Phoenix ICON wide-field infant fundus image. 1240 x 1240 pixels.
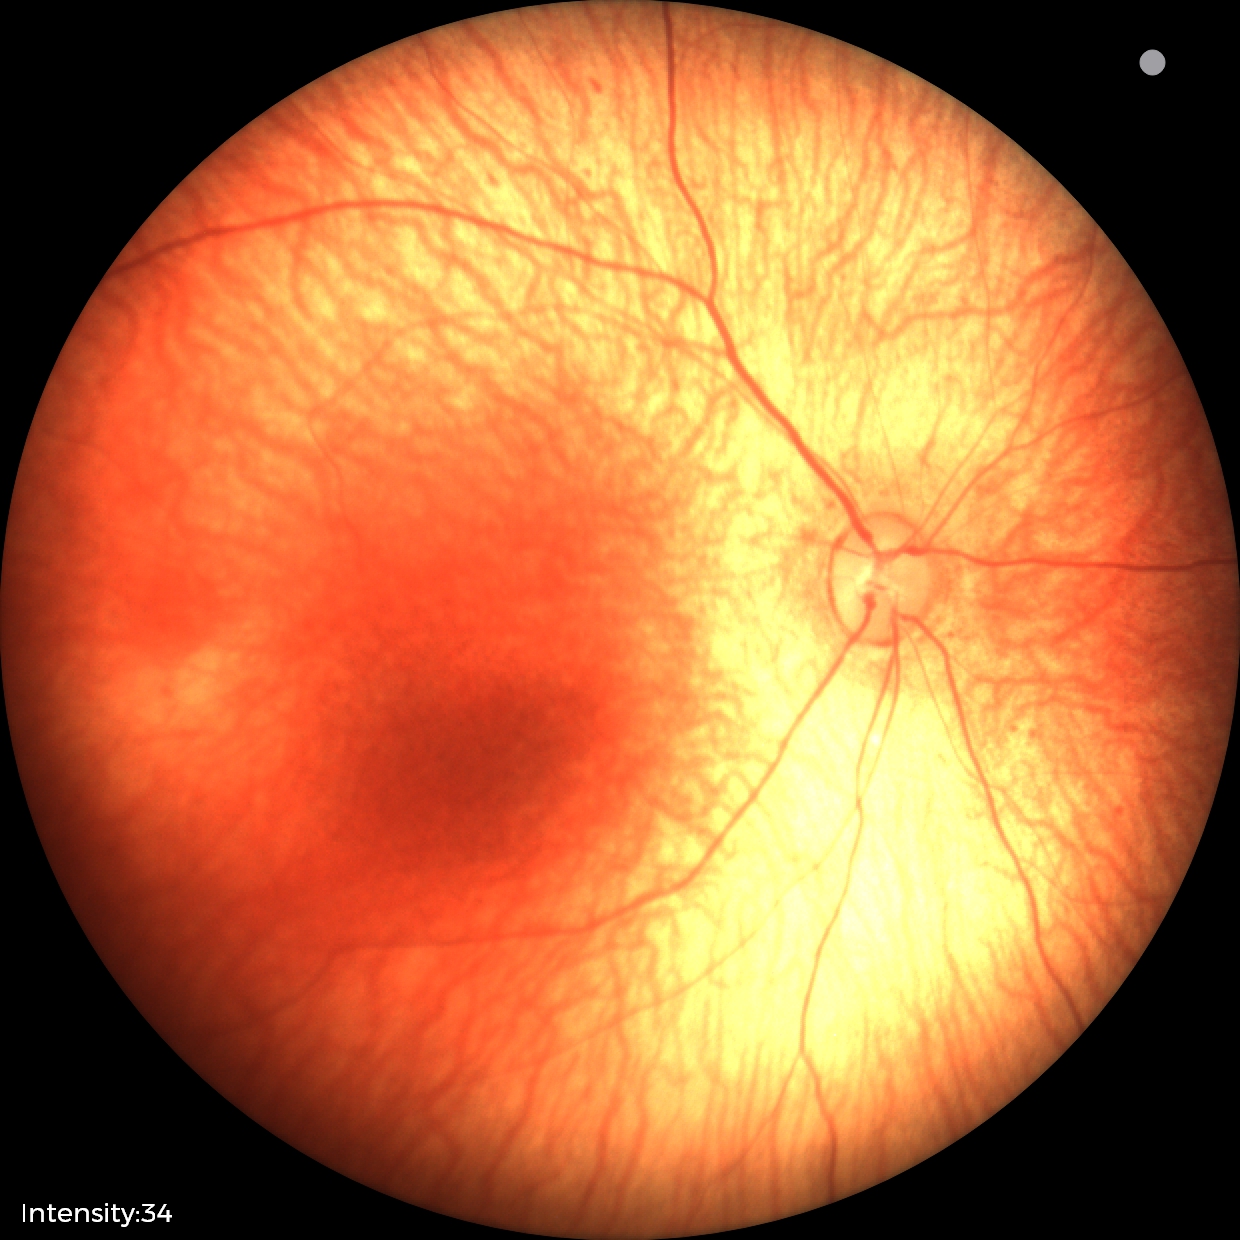 Examination with physiological retinal findings.